2346 x 1568 pixels
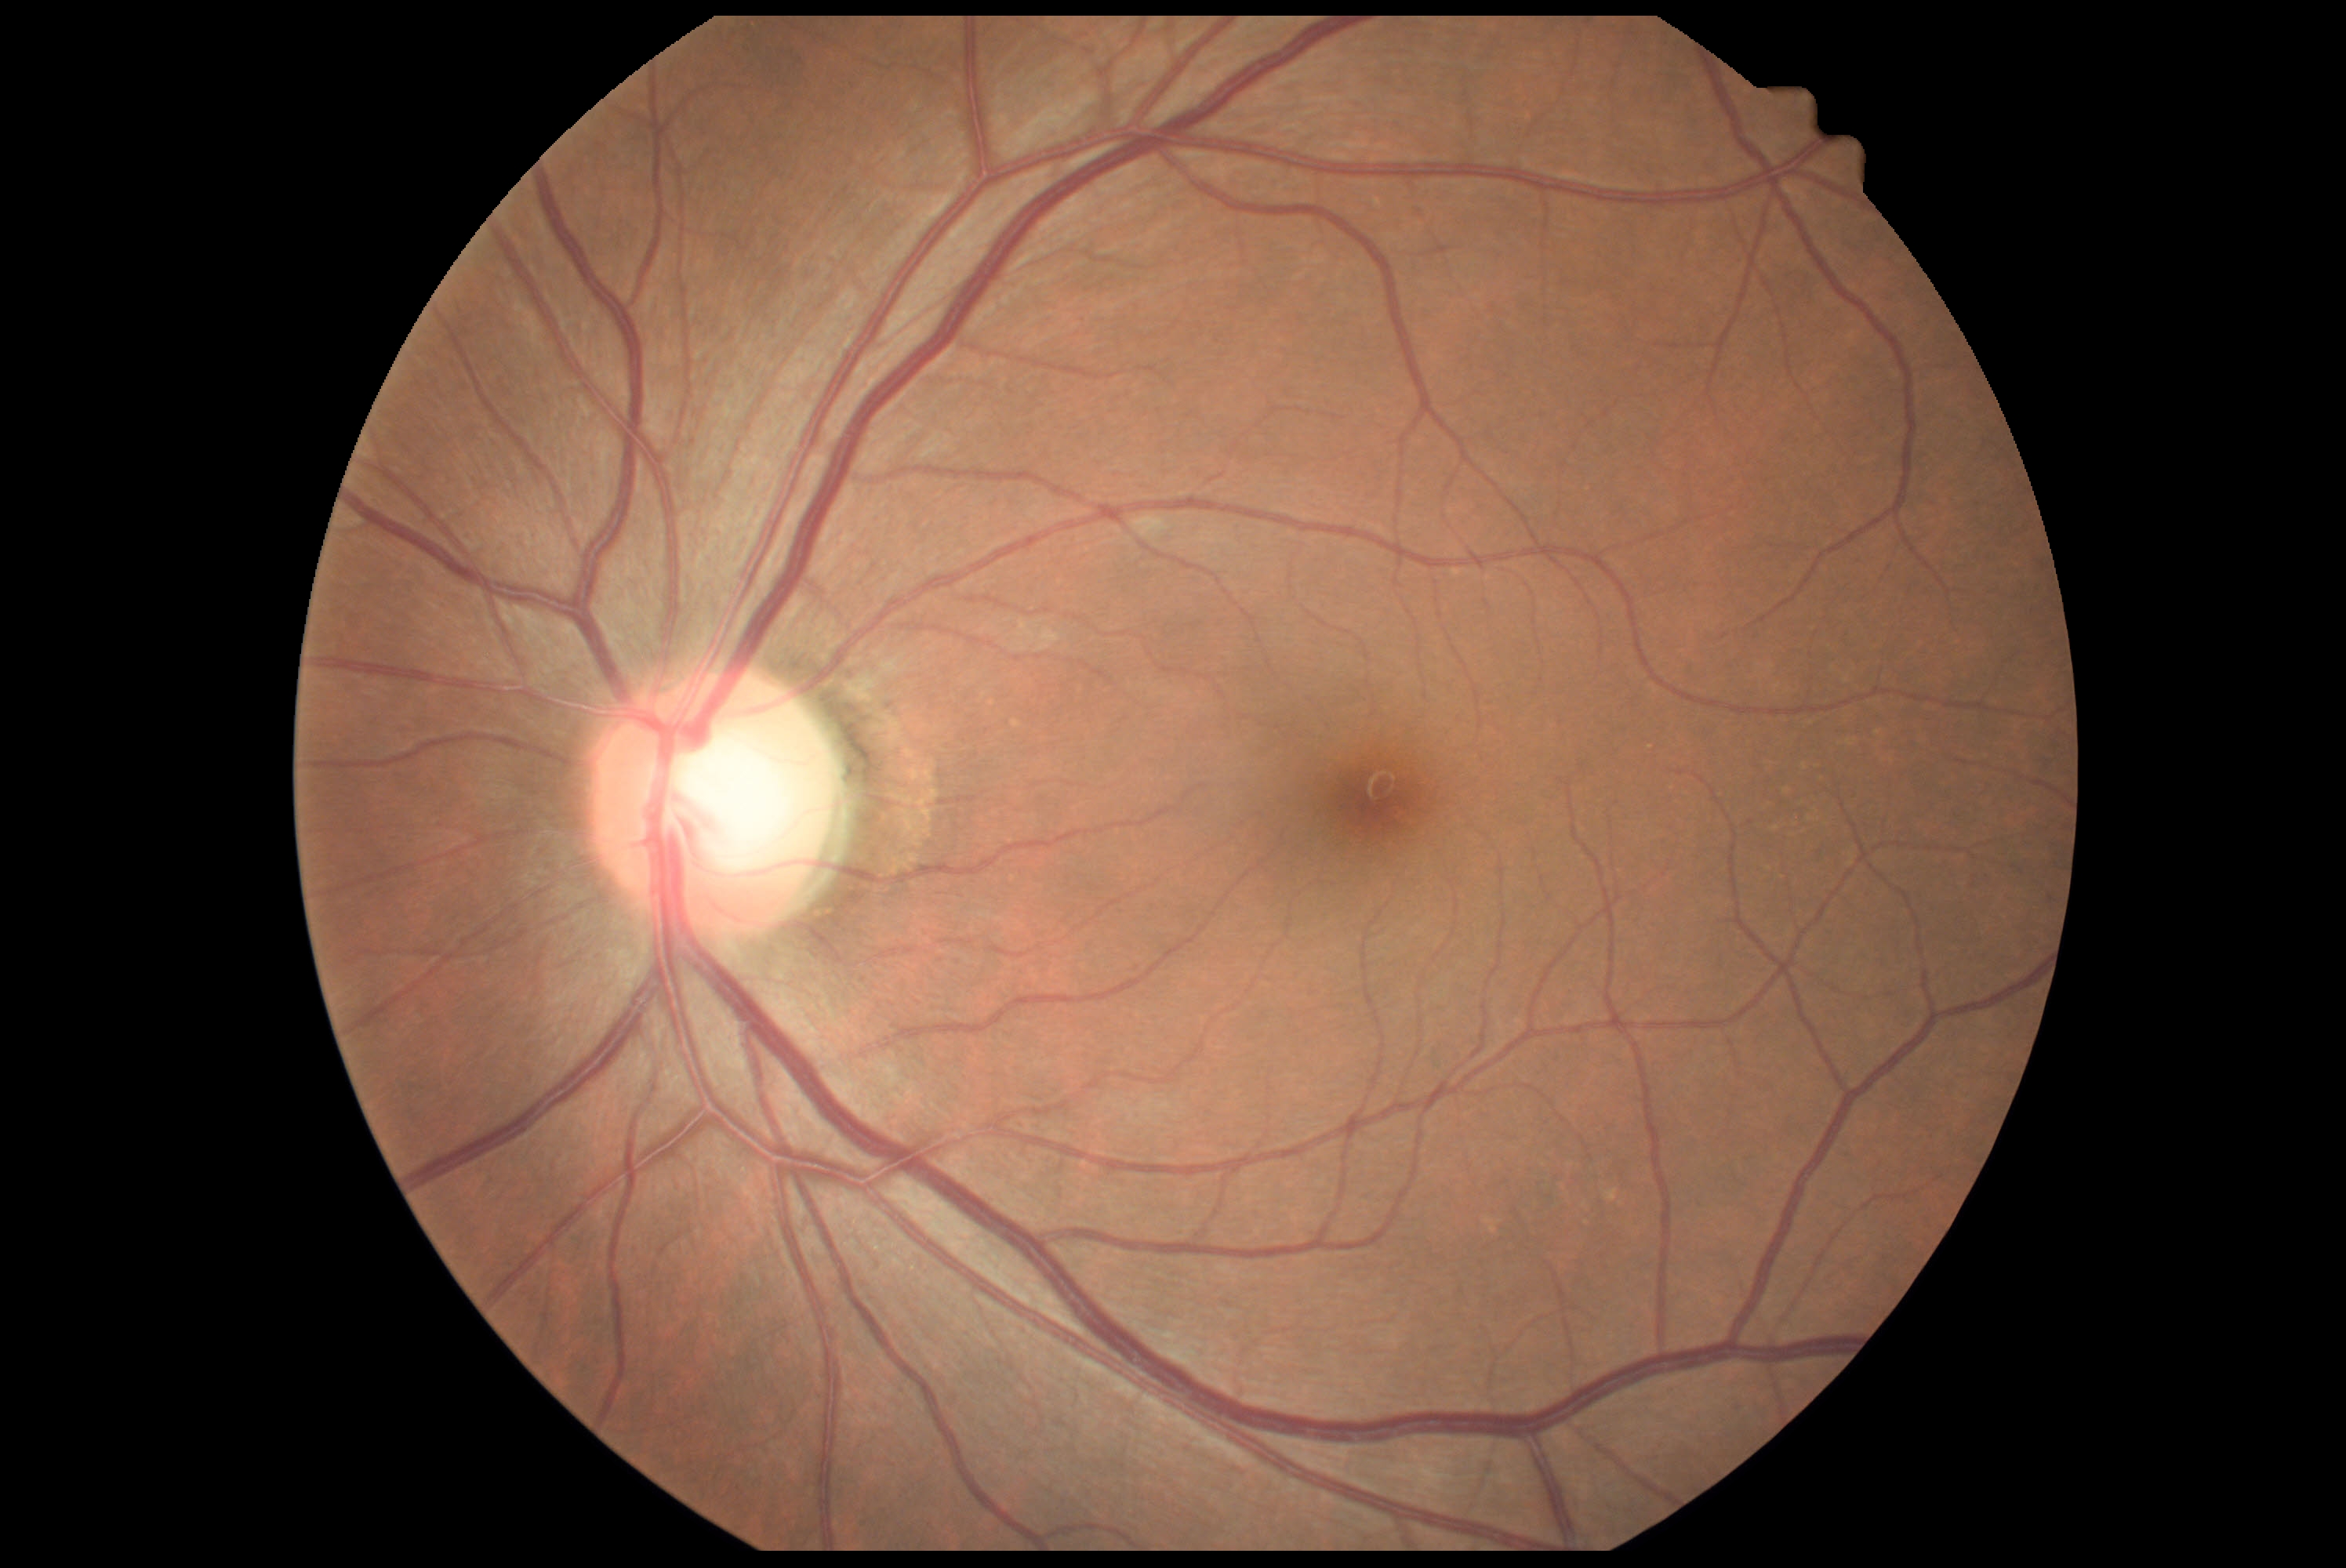 DR grade: no apparent retinopathy (0).